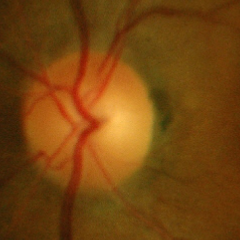

Optic nerve head appearance consistent with no glaucomatous findings.